Davis DR grading:
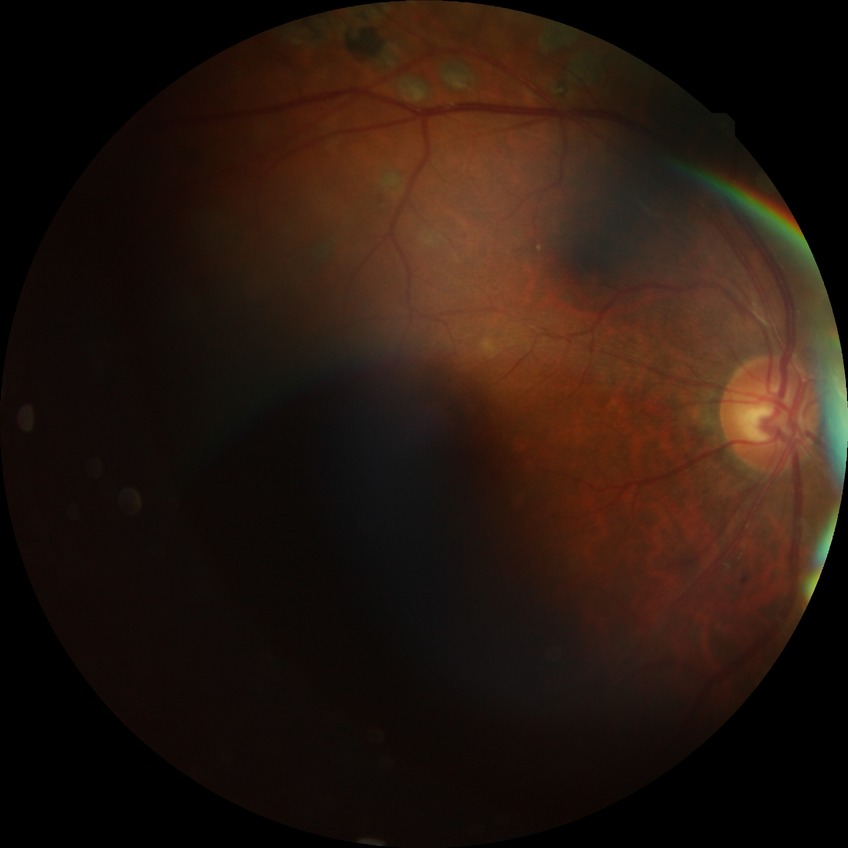 davis_grade: proliferative diabetic retinopathy